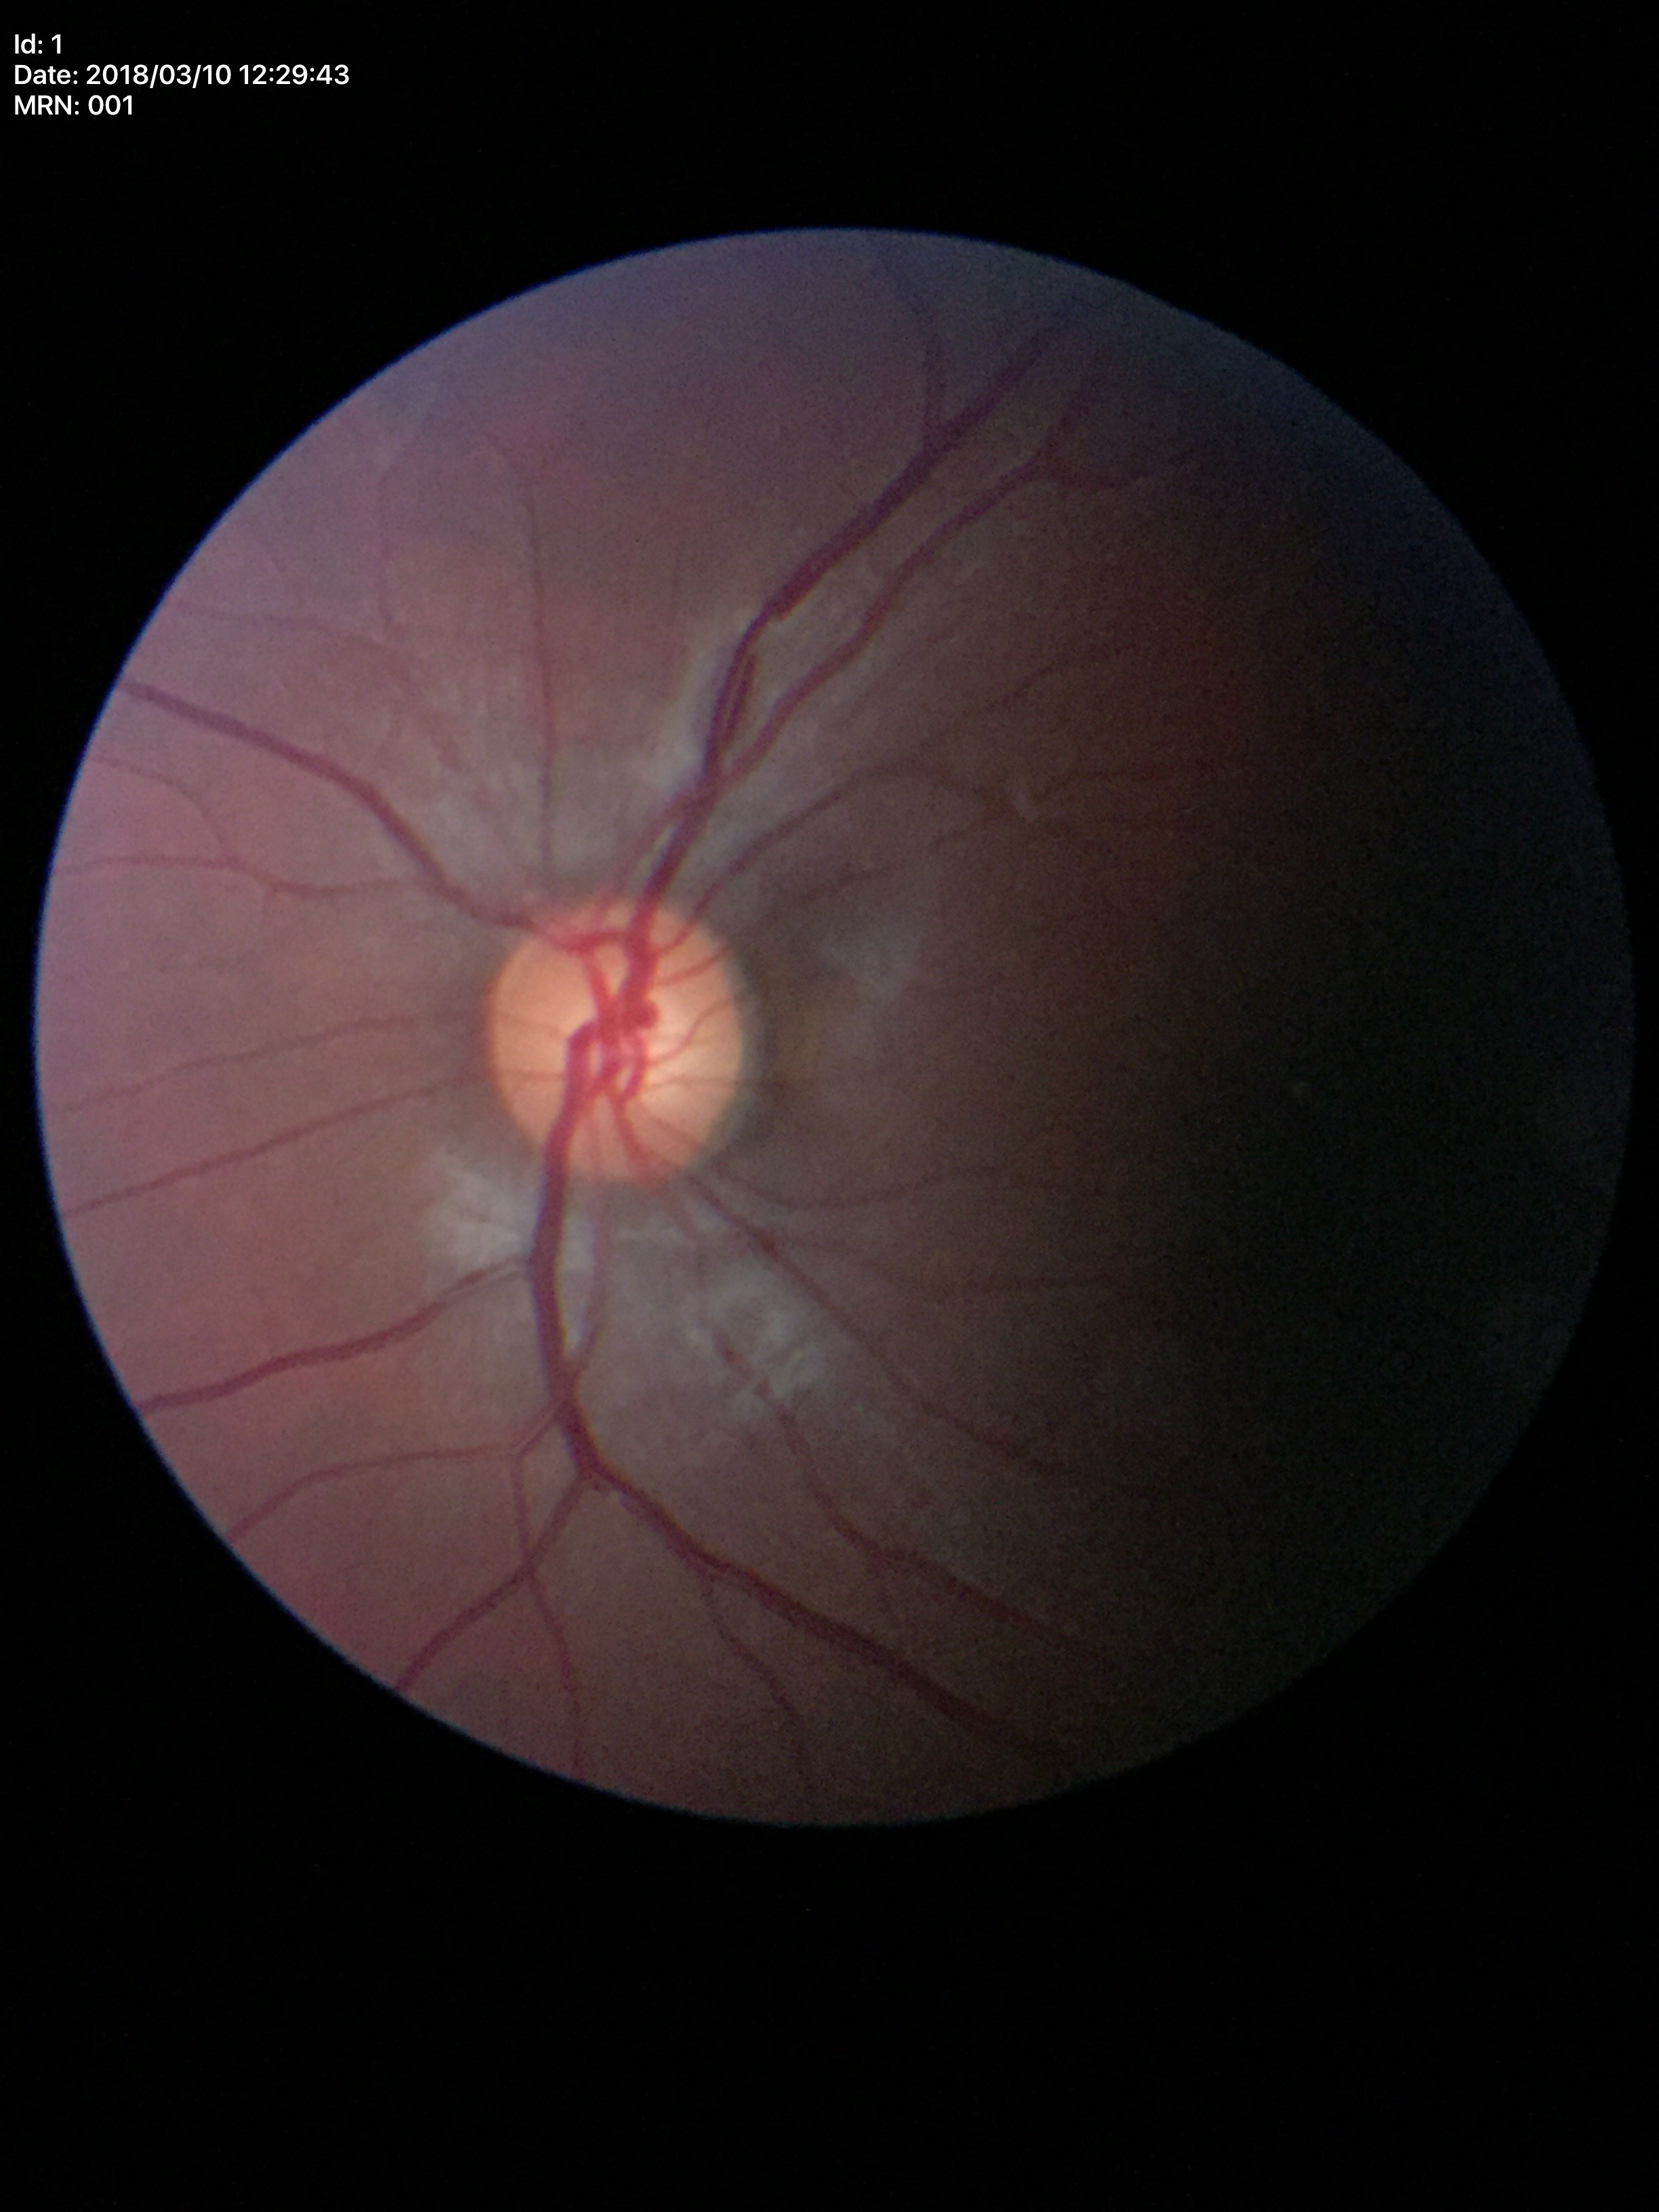

Glaucoma evaluation: no suspicious findings | vertical CDR: 0.50.